Fundus photo.
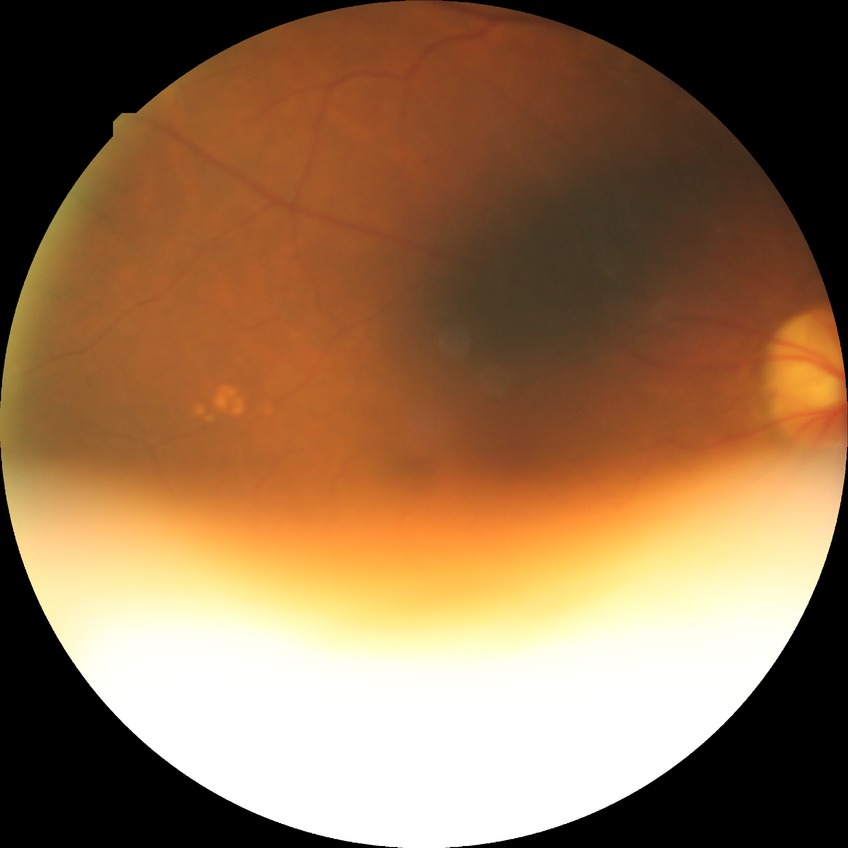

Davis DR grade@NDR, DR impression@no signs of DR.